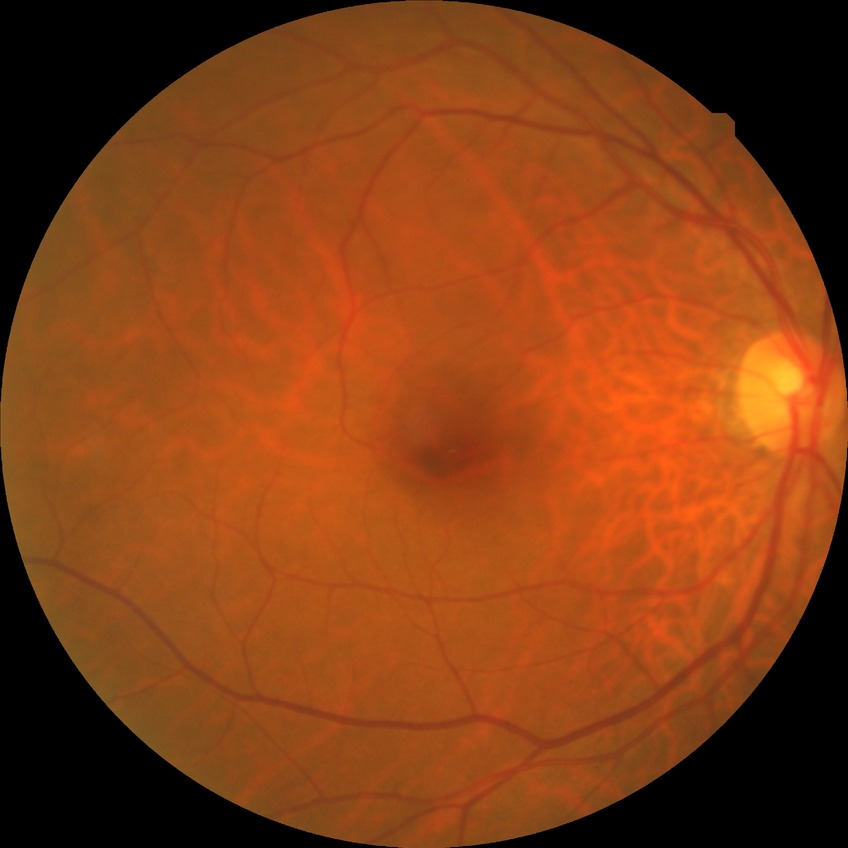 Diabetic retinopathy (DR): no diabetic retinopathy (NDR).